CFP · Davis DR grading
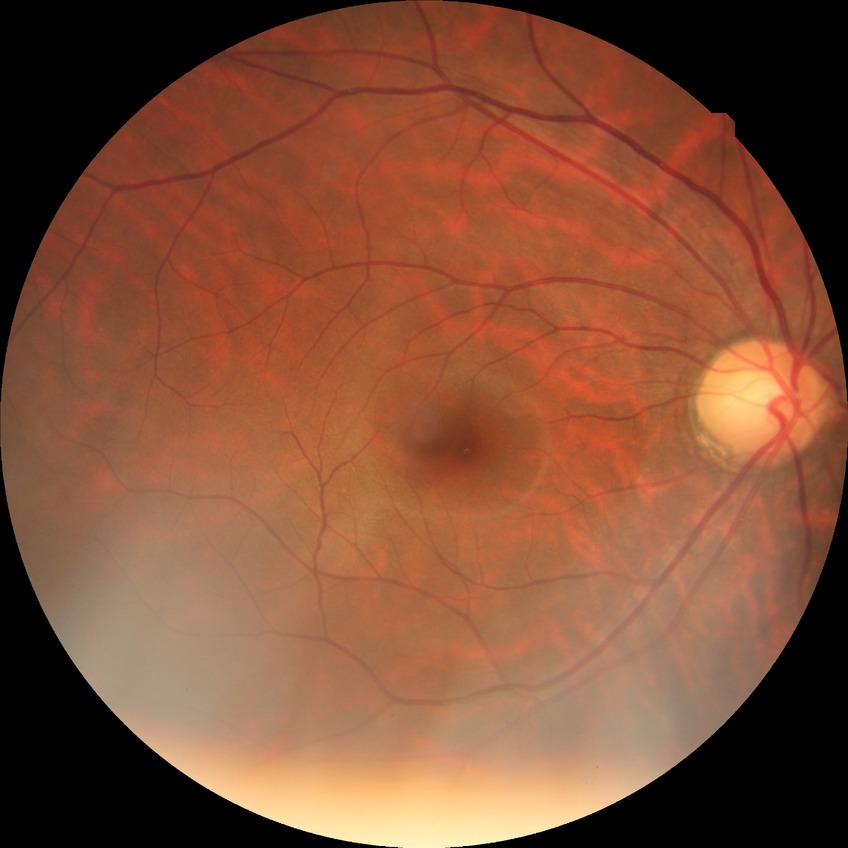
DR@NDR.